45° FOV: 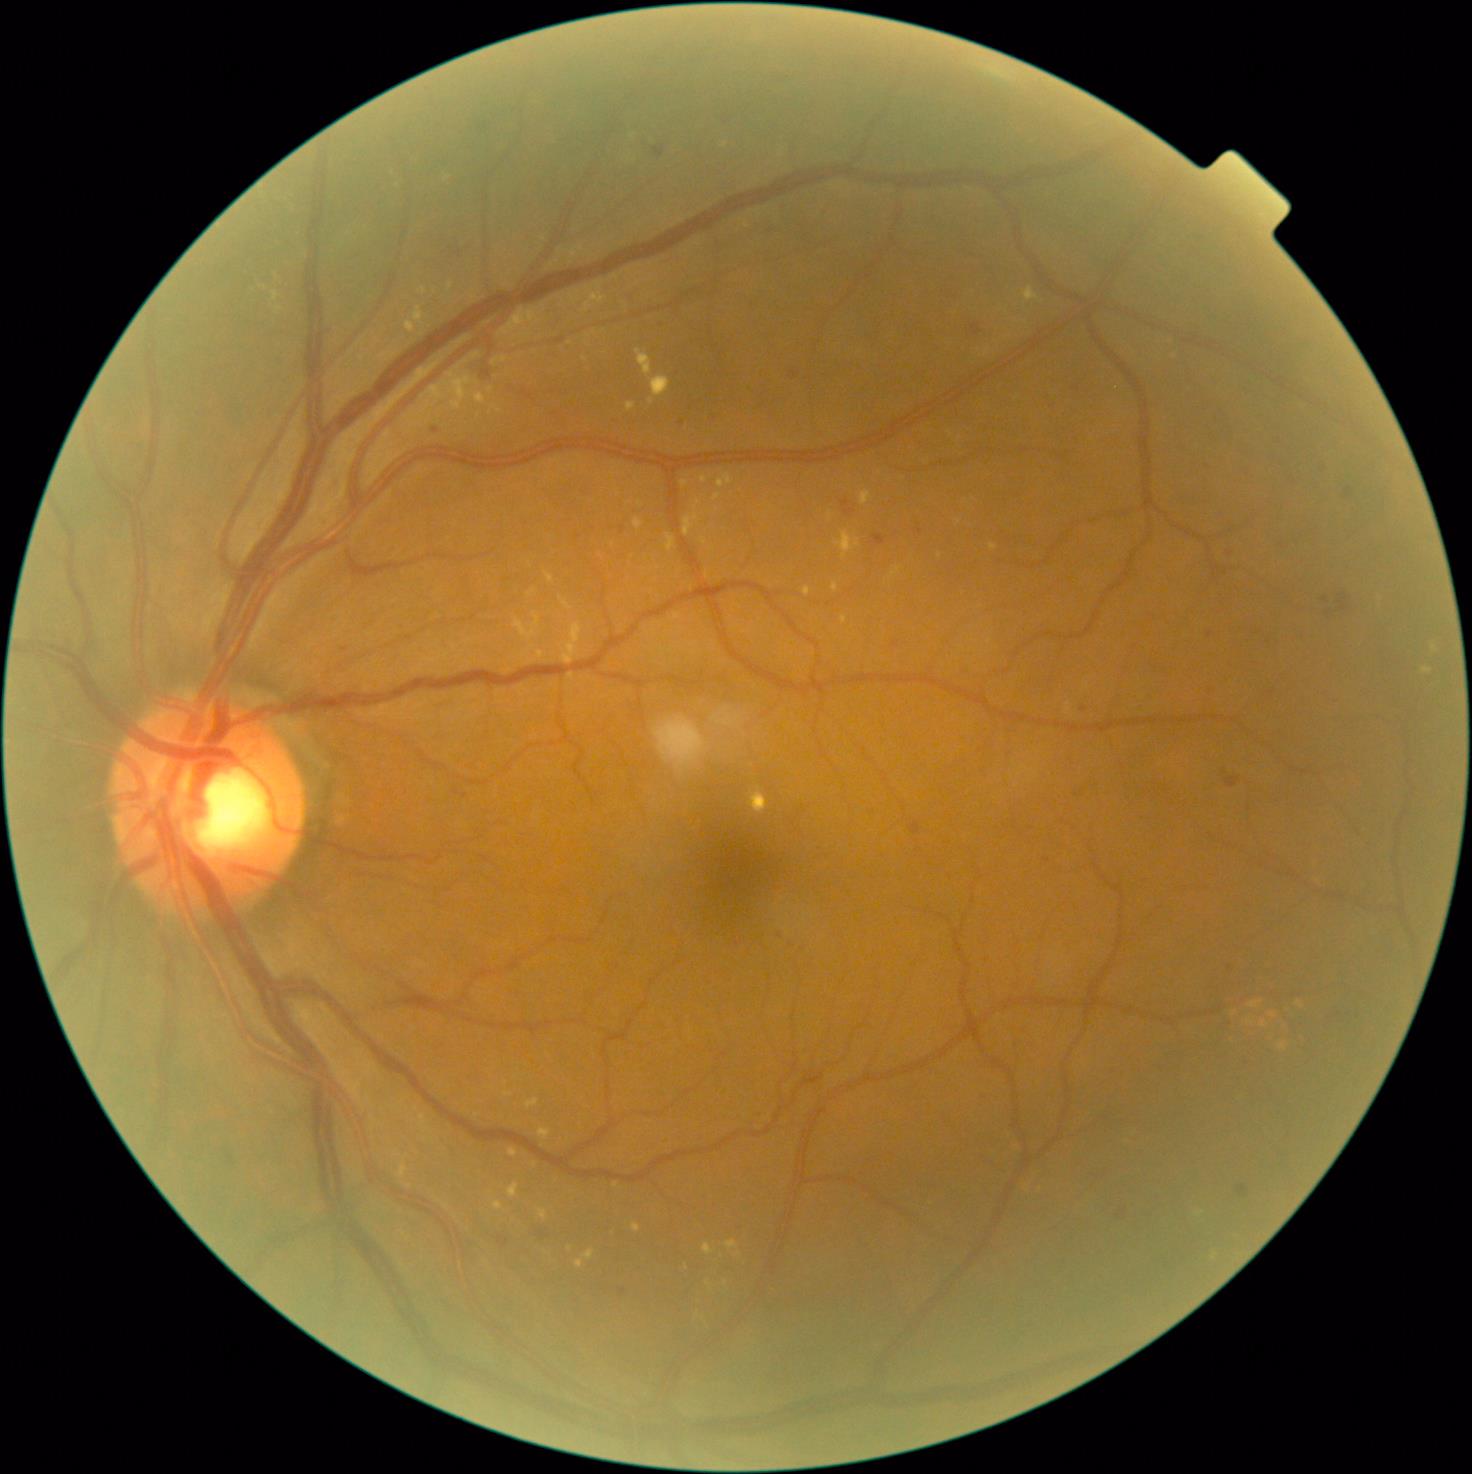 Diabetic retinopathy (DR): grade 2
Lesions identified (partial list):
hard exudates (EXs) (more not shown): (405, 359, 486, 434) | (626, 402, 637, 412) | (273, 292, 280, 302) | (750, 788, 769, 814) | (509, 1182, 519, 1198) | (414, 306, 425, 338) | (667, 534, 675, 551) | (509, 1148, 519, 1157)
EXs (small, approximate centers) near [535, 1164] | [830, 515] | [1300, 1005] | [652, 401] | [686, 1266] | [579, 1263] | [1274, 1015] | [448, 179]
hemorrhages (HEs): (1338, 594, 1350, 612) | (1225, 776, 1241, 788) | (499, 1235, 509, 1248)
HEs (small, approximate centers) near [1328, 614] | [1325, 600]
microaneurysms (MAs): (792, 372, 800, 379) | (483, 371, 492, 378) | (845, 508, 855, 516) | (538, 1231, 546, 1238) | (1346, 488, 1351, 498) | (970, 323, 982, 336) | (1117, 1210, 1127, 1217) | (840, 500, 850, 508) | (654, 147, 665, 158) | (873, 536, 886, 546) | (1238, 1185, 1248, 1197) | (911, 822, 921, 834)
MAs (small, approximate centers) near [622, 1292] | [1230, 553] | [1084, 710] | [436, 431] | [1210, 635] | [738, 943]
soft exudates (SEs): none detected